CFP: 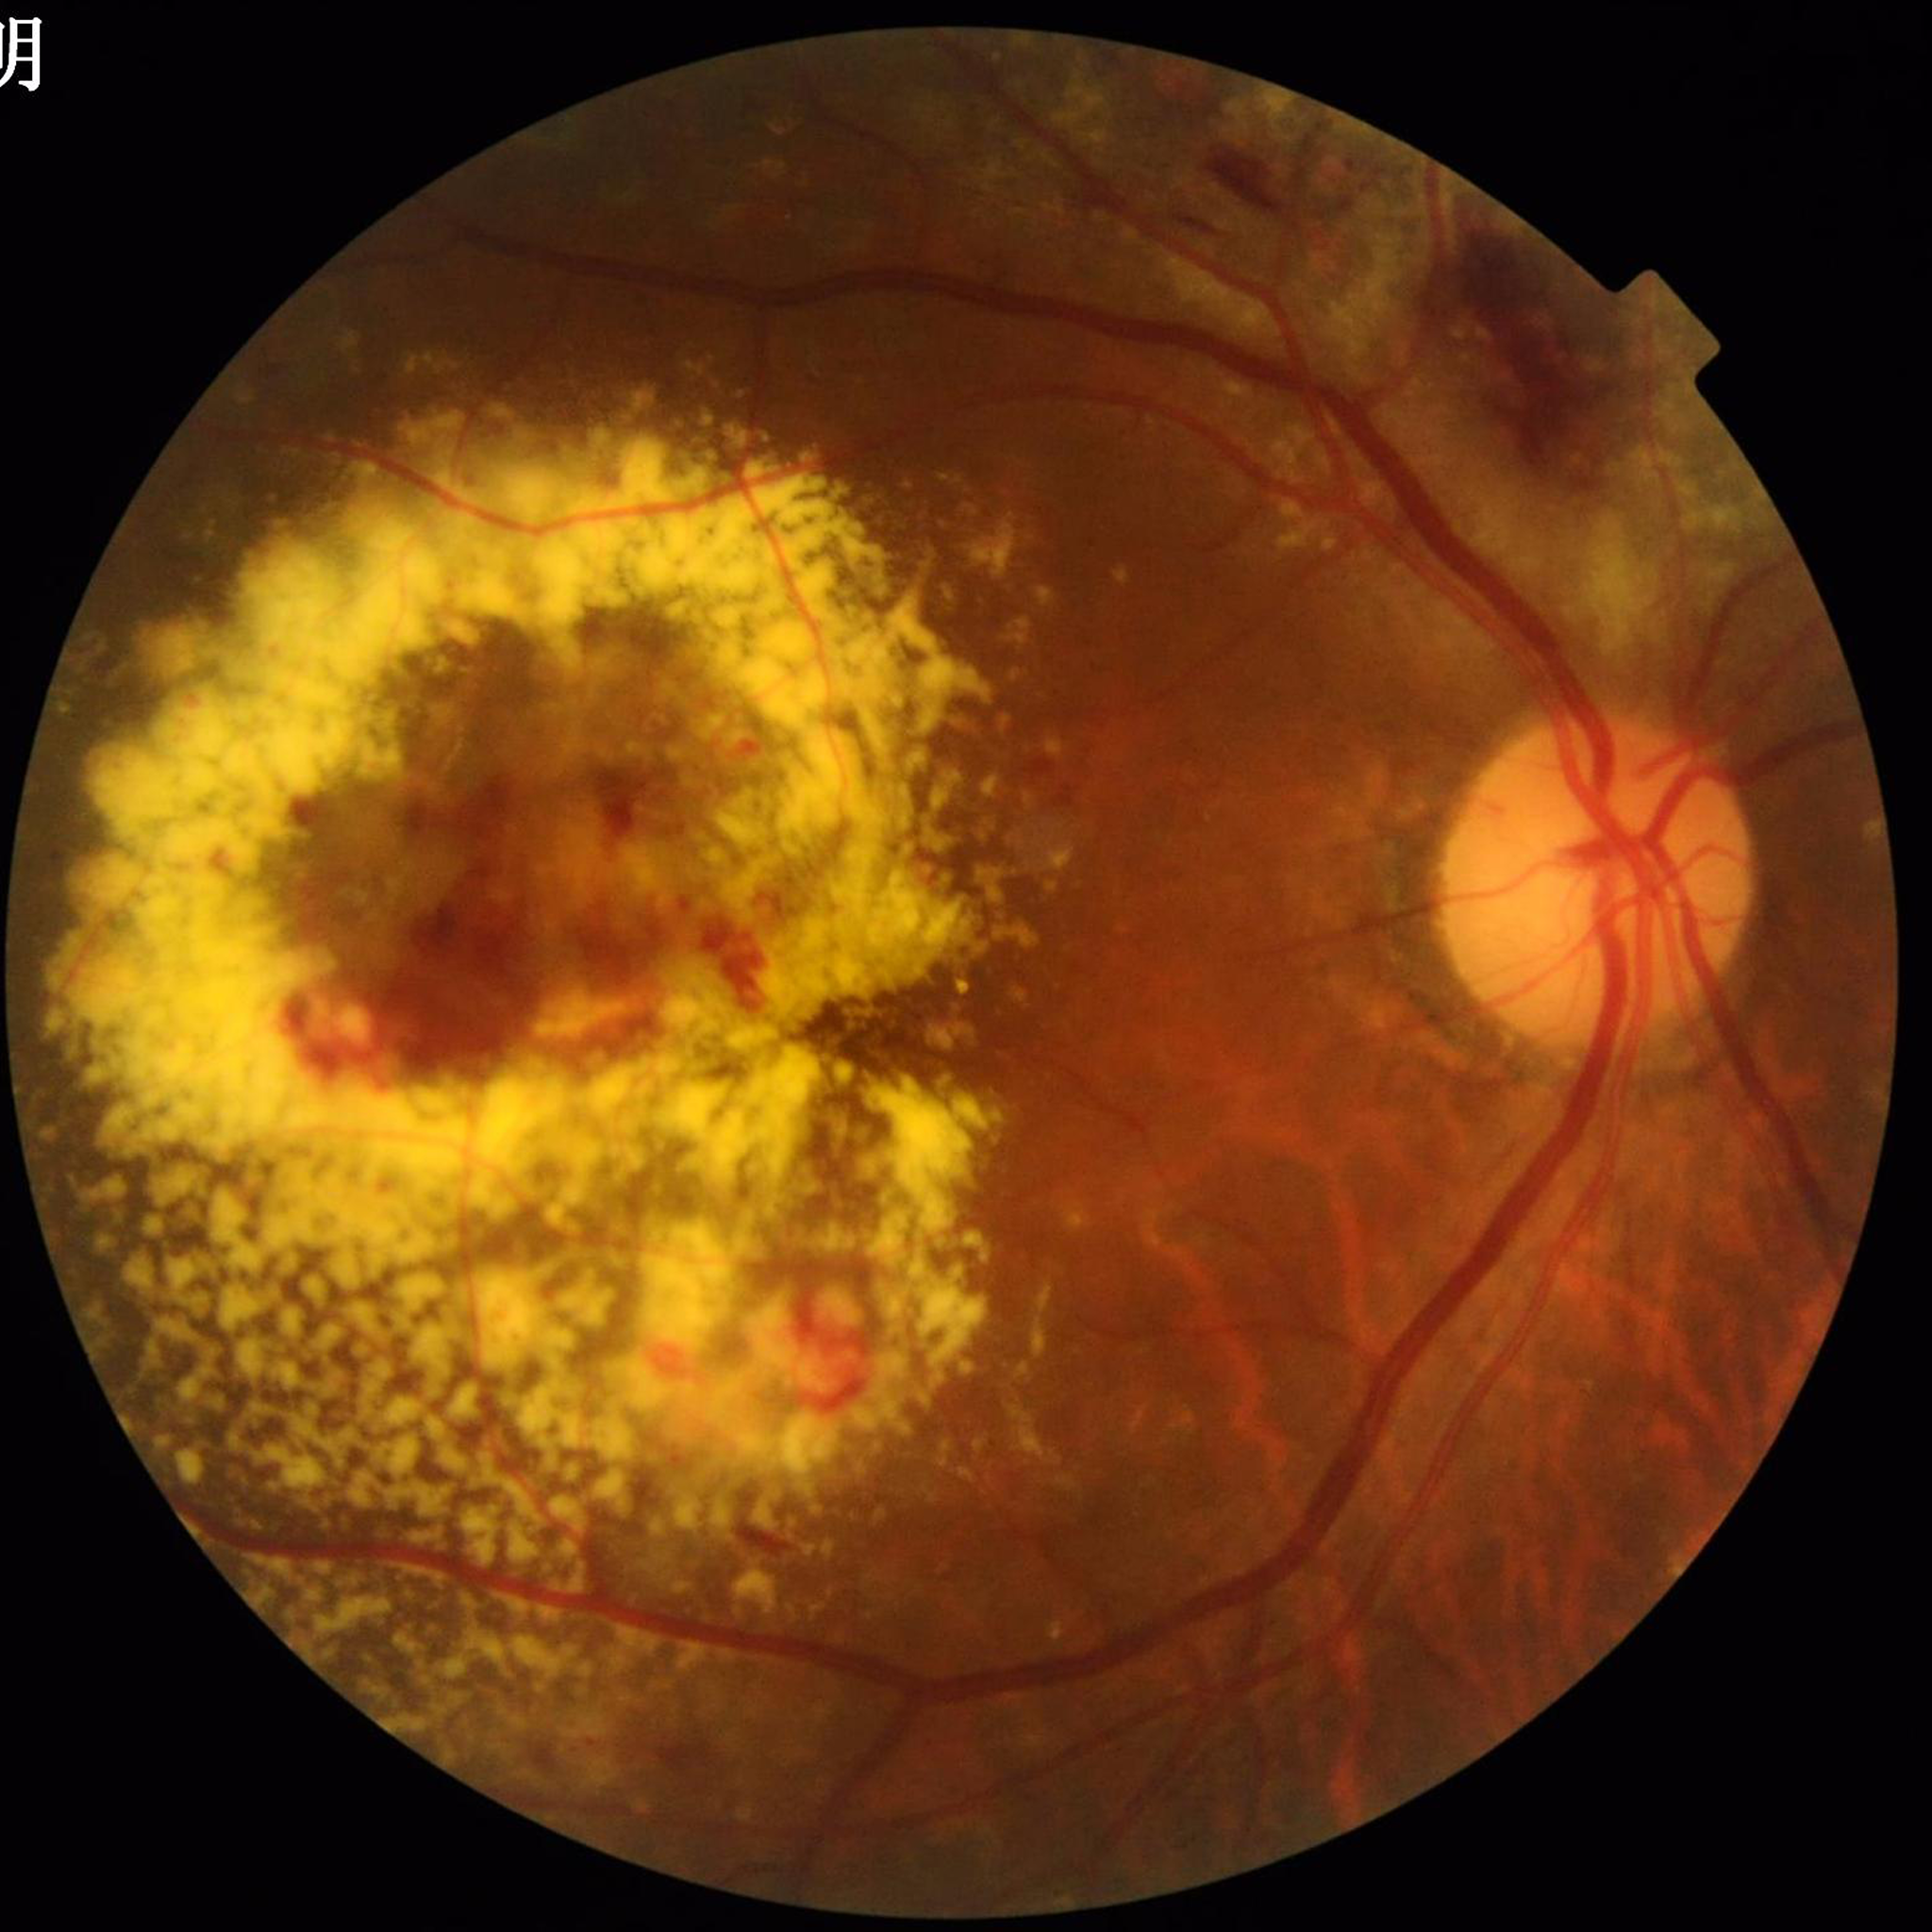

Image quality: no blur, illumination and color satisfactory, contrast adequate.
Diagnosed with diabetic retinopathy (DR).